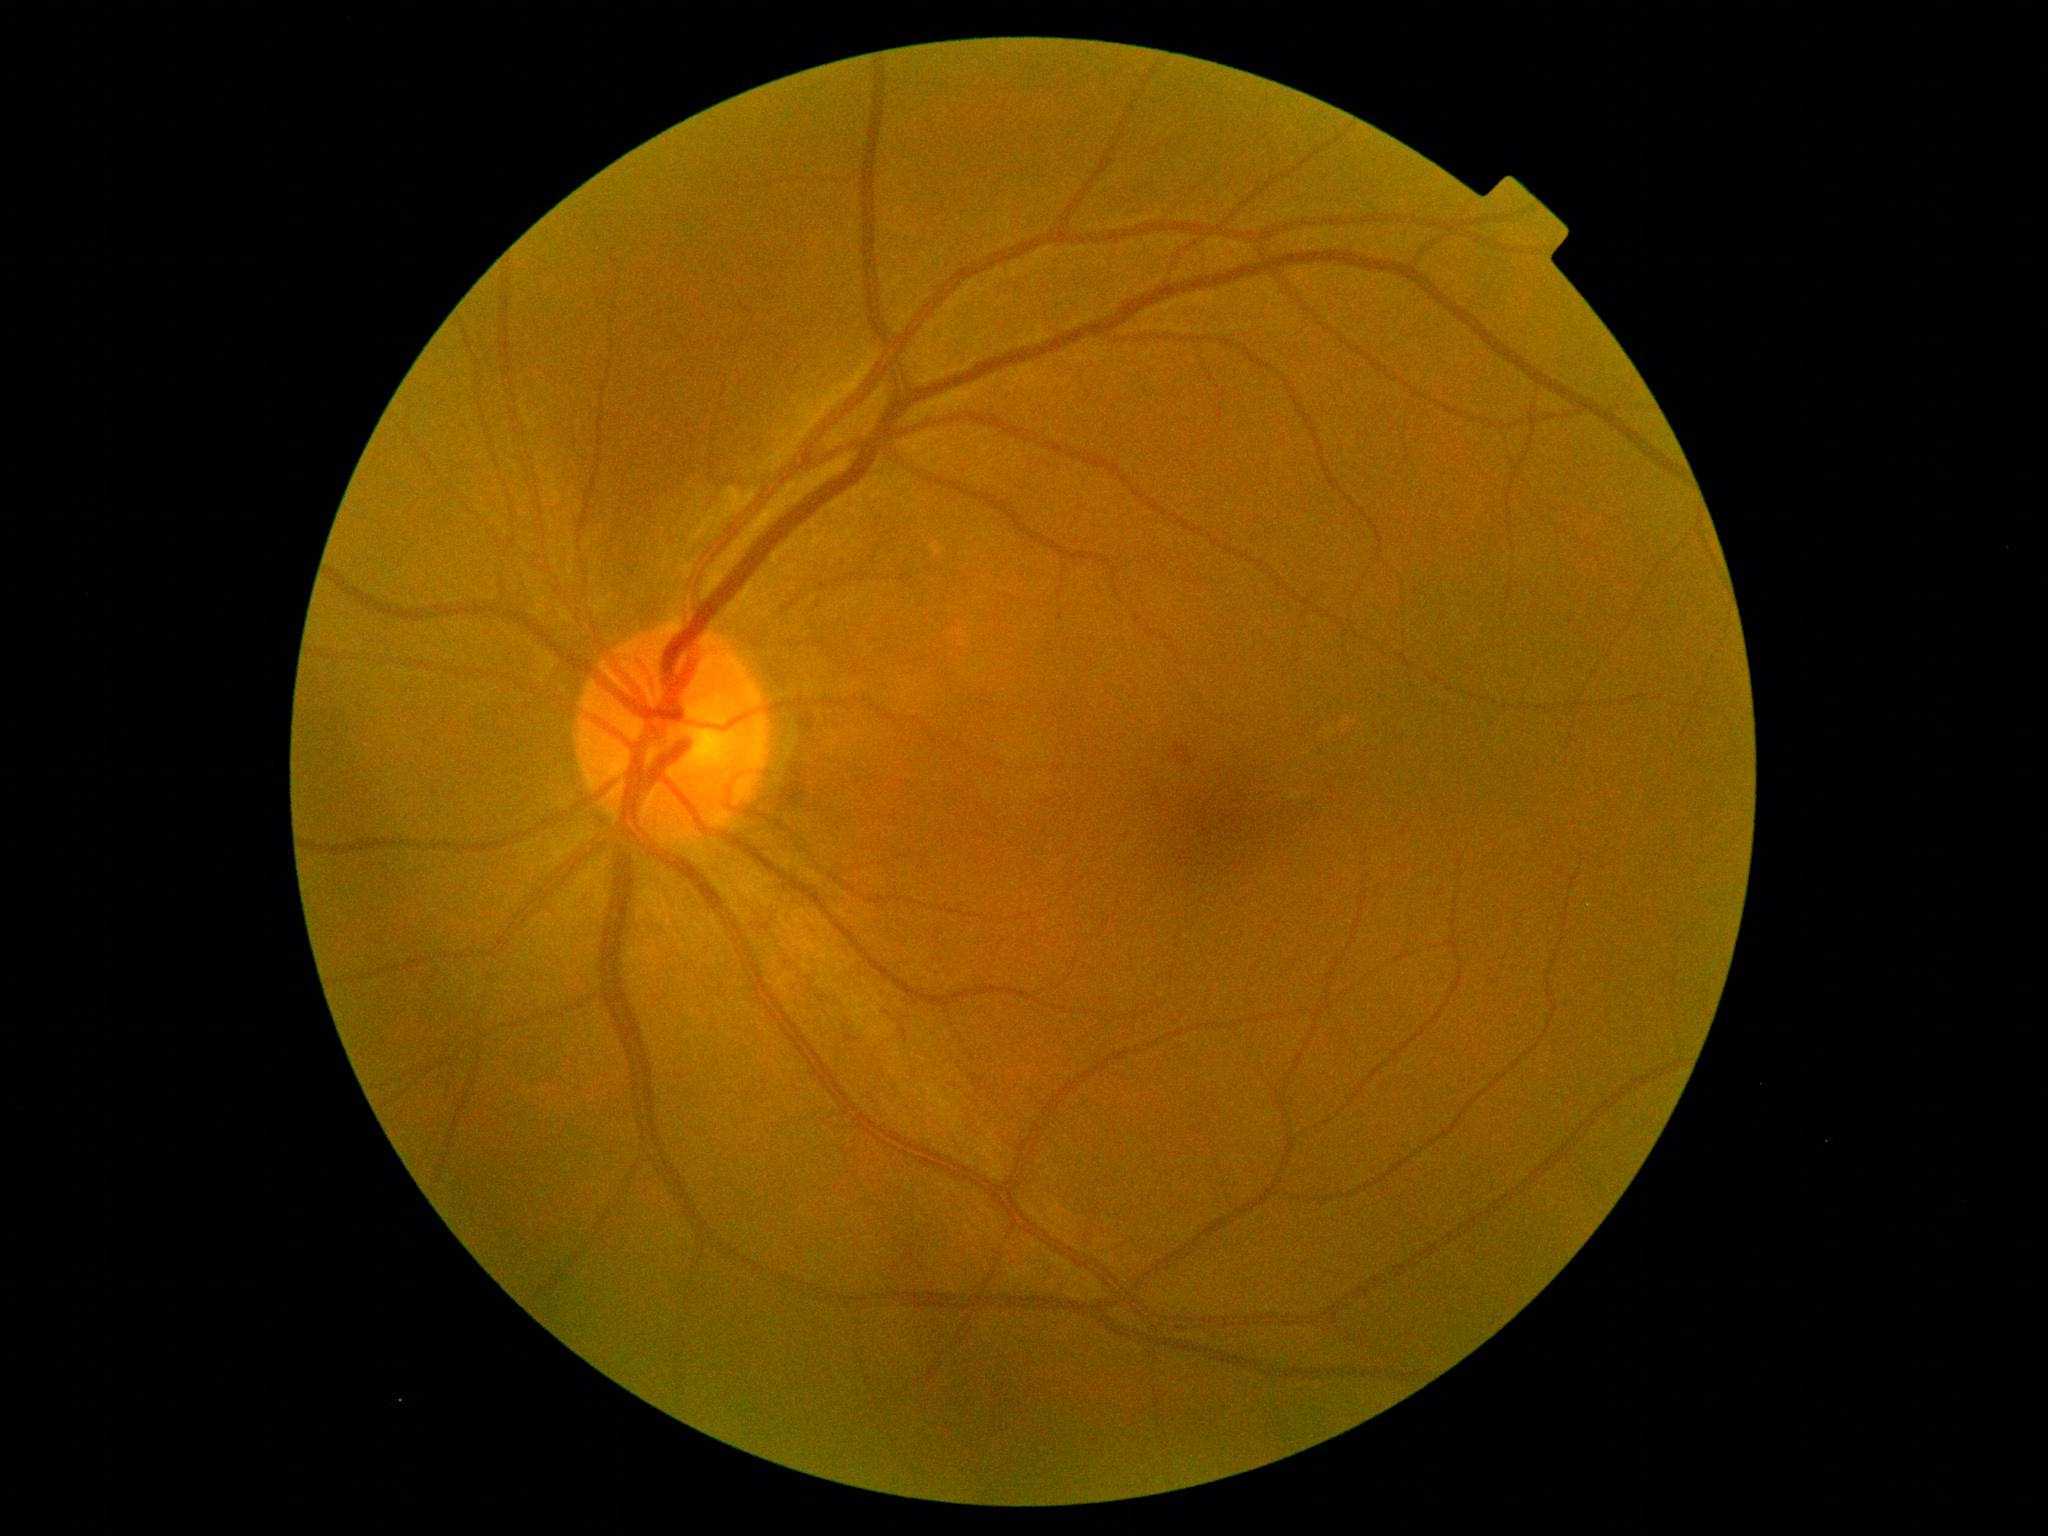
diabetic retinopathy severity = 2/4.